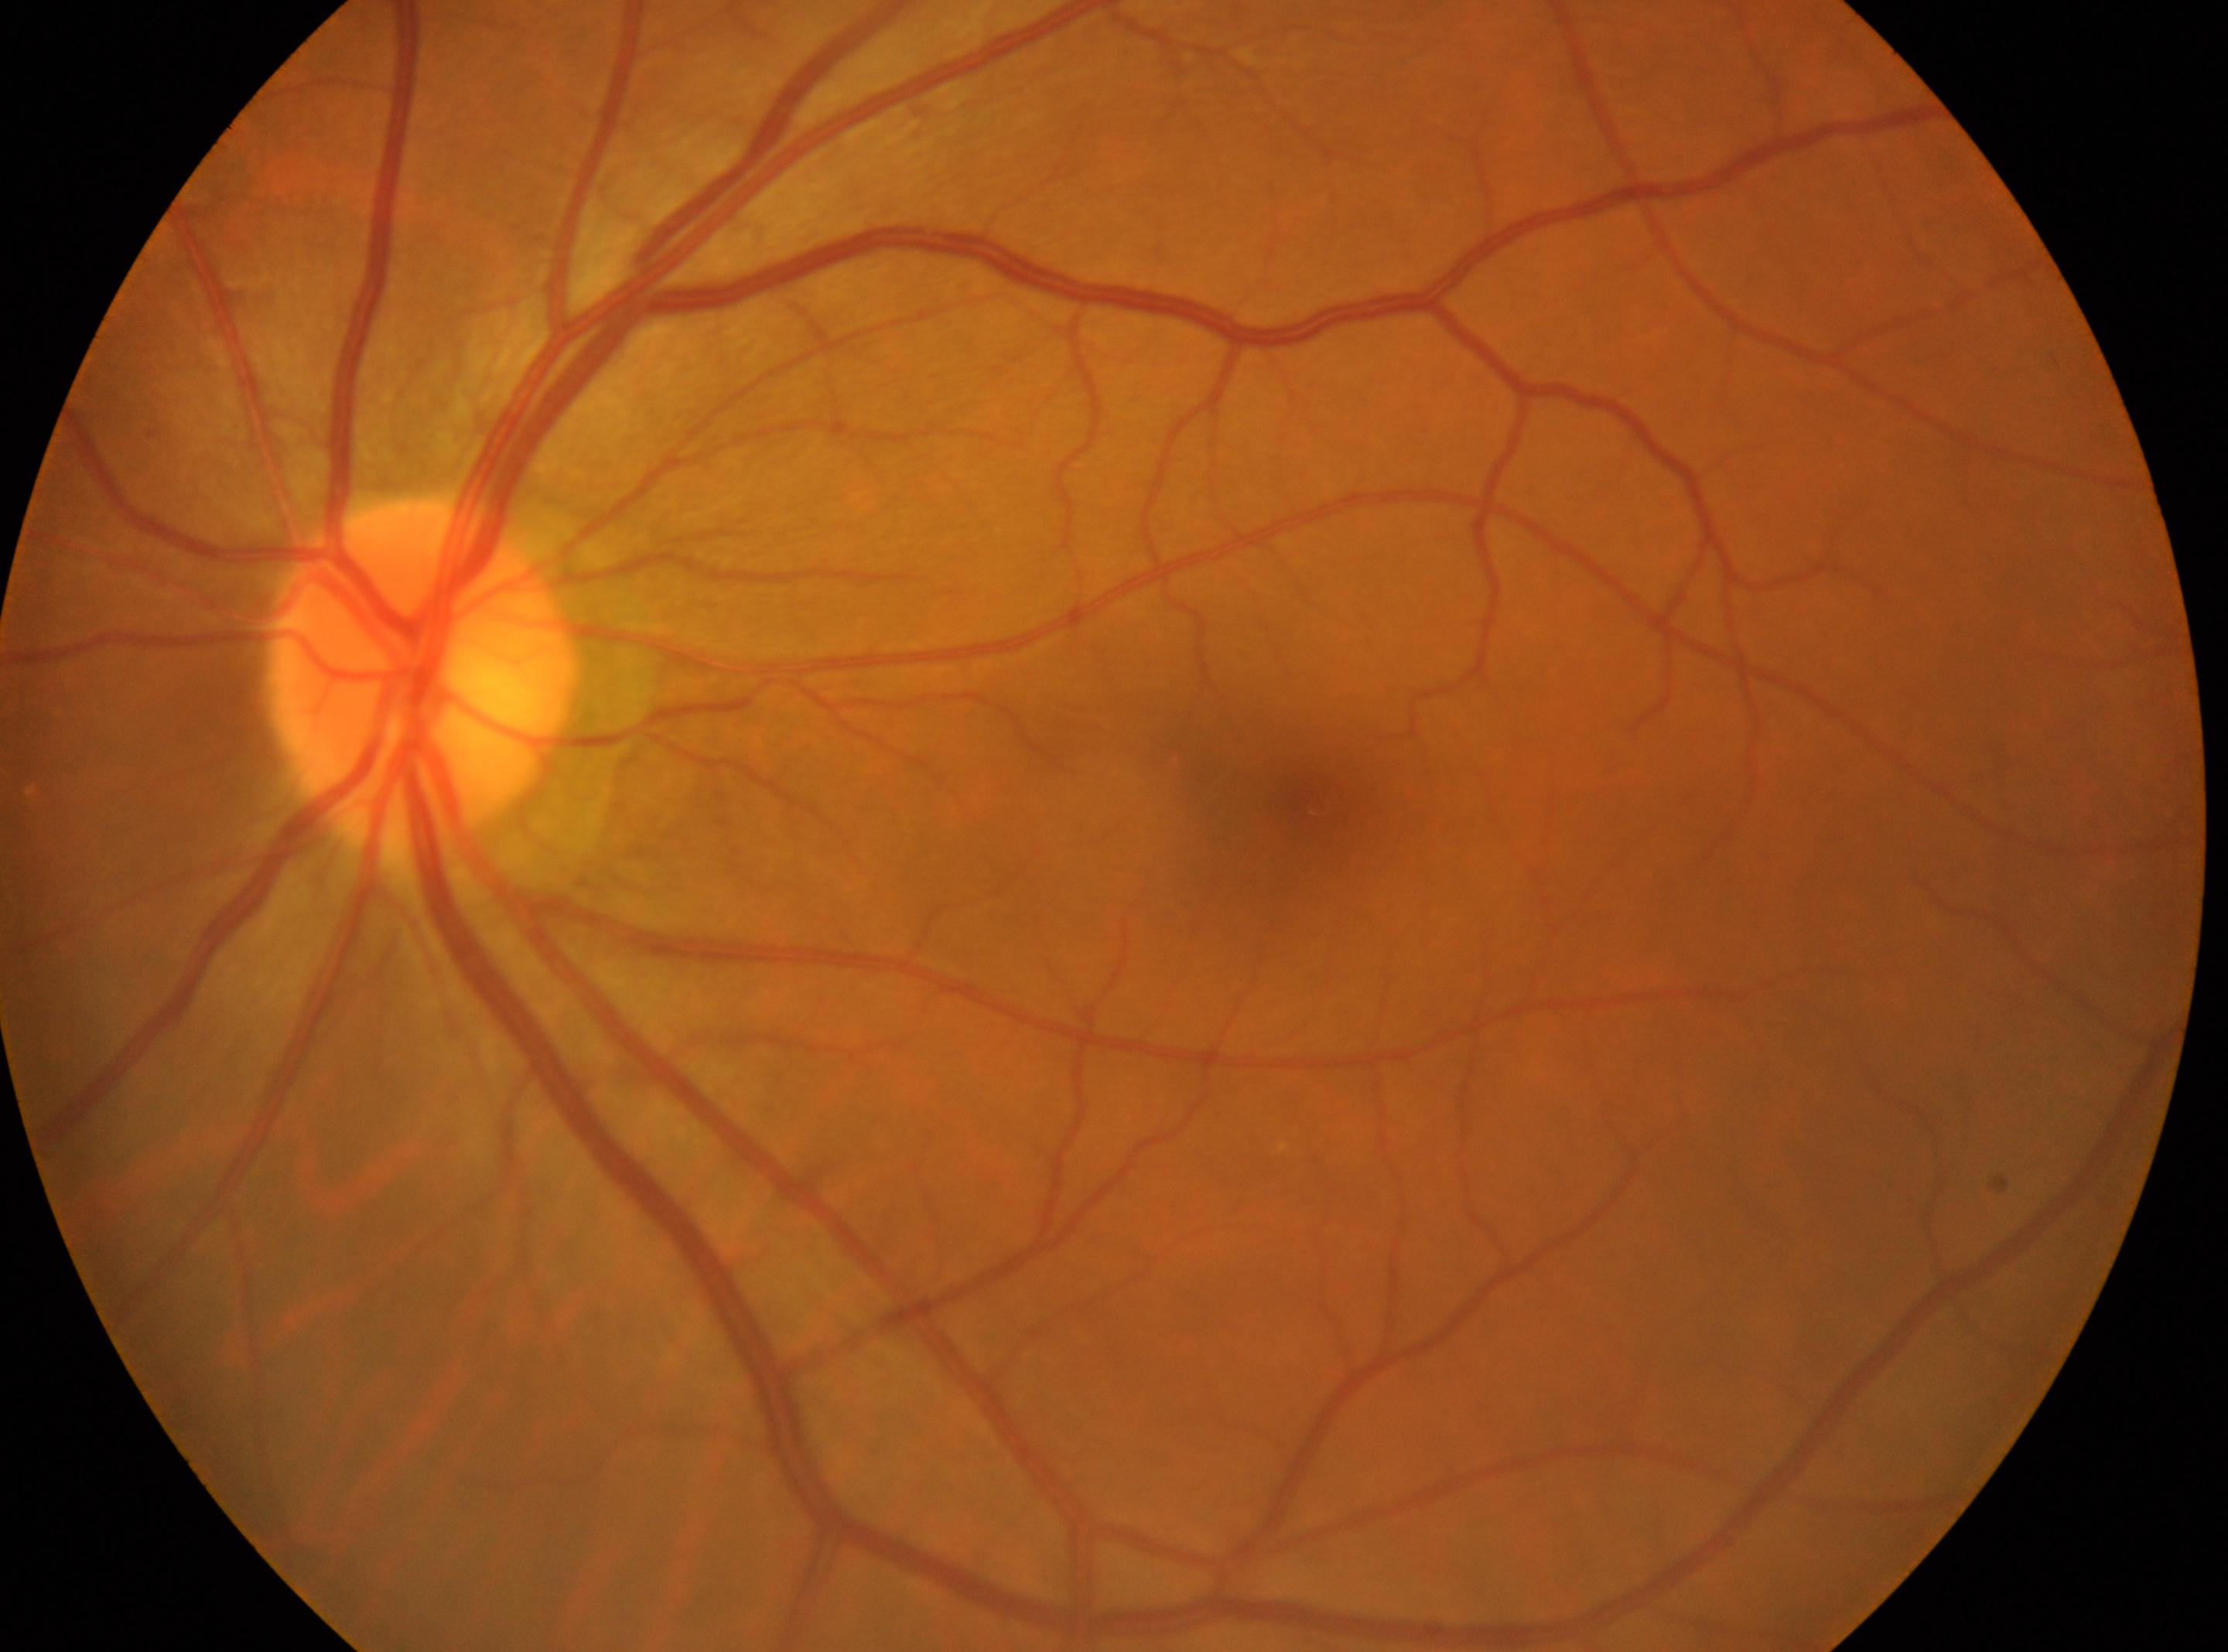
The macular center is at 1315, 806. Eye: oculus sinister. No DR findings. Retinopathy grade is 0. Optic disk located at 419, 678.